1240x1240. Phoenix ICON, 100° FOV. Wide-field fundus photograph from neonatal ROP screening — 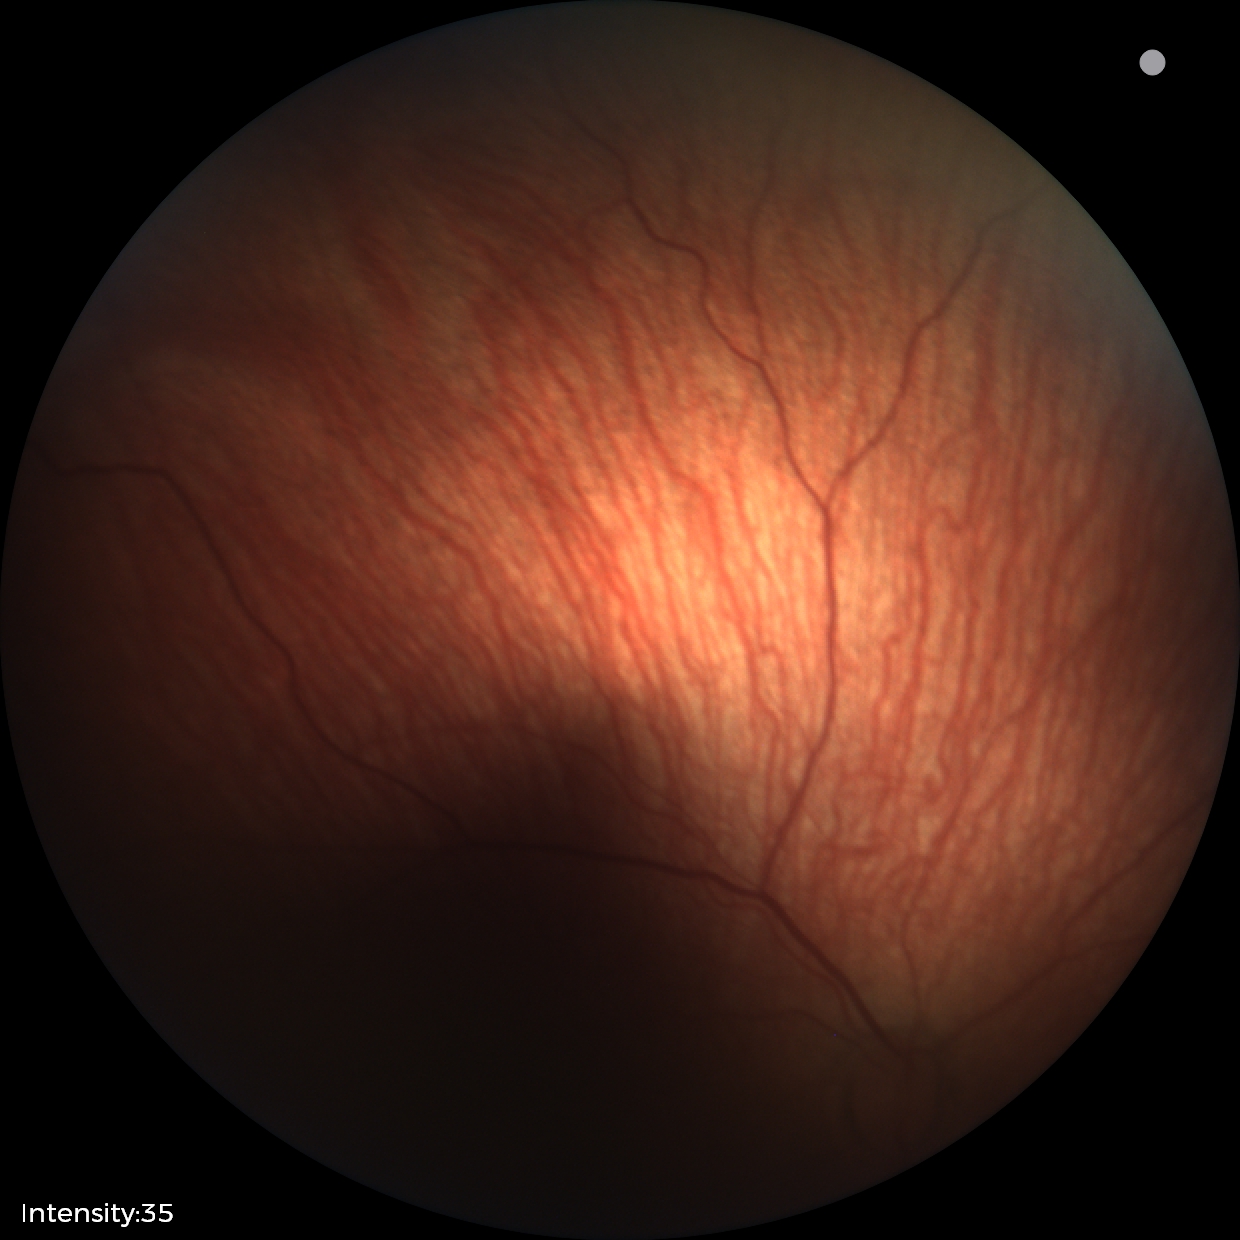
Plus disease absent.
Diagnosis from this screening exam: status post retinopathy of prematurity — retinal appearance after treated retinopathy of prematurity.